50° FOV. 2228x1652.
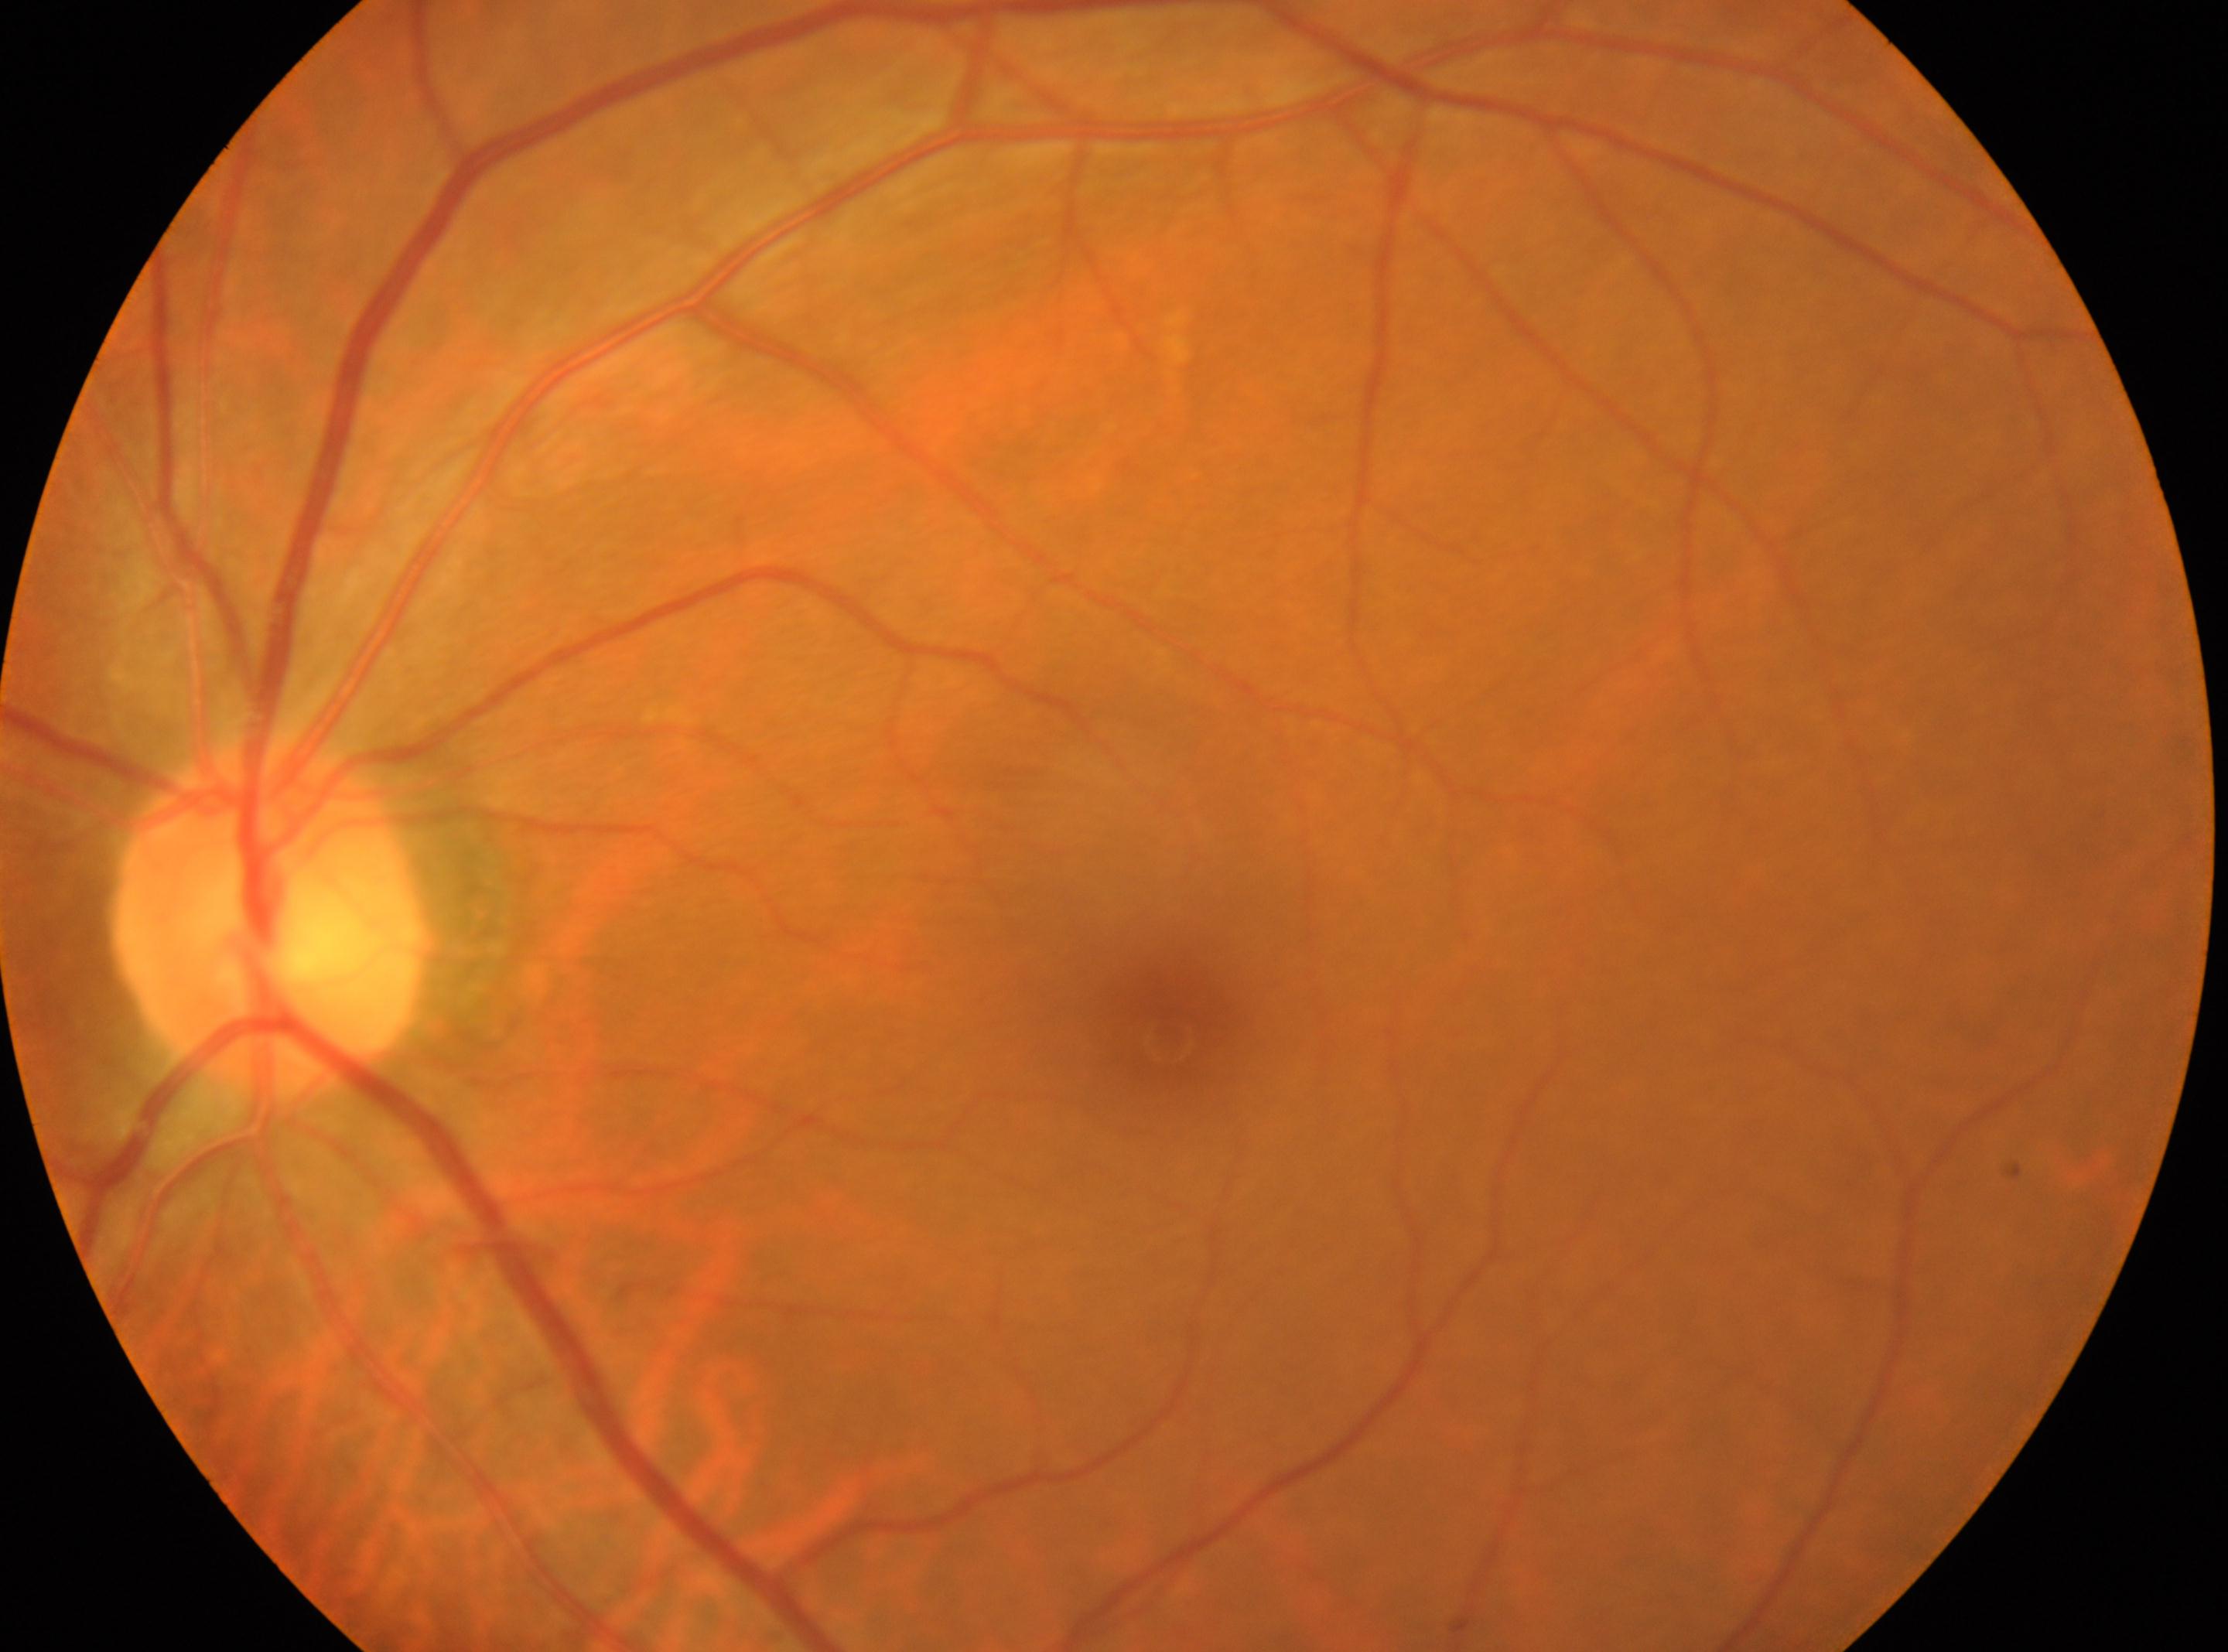
Diabetic retinopathy severity is grade 0 (no apparent retinopathy). Fovea center located at (x: 1171, y: 1039). The image shows the left eye. The ONH is at (x: 274, y: 914).